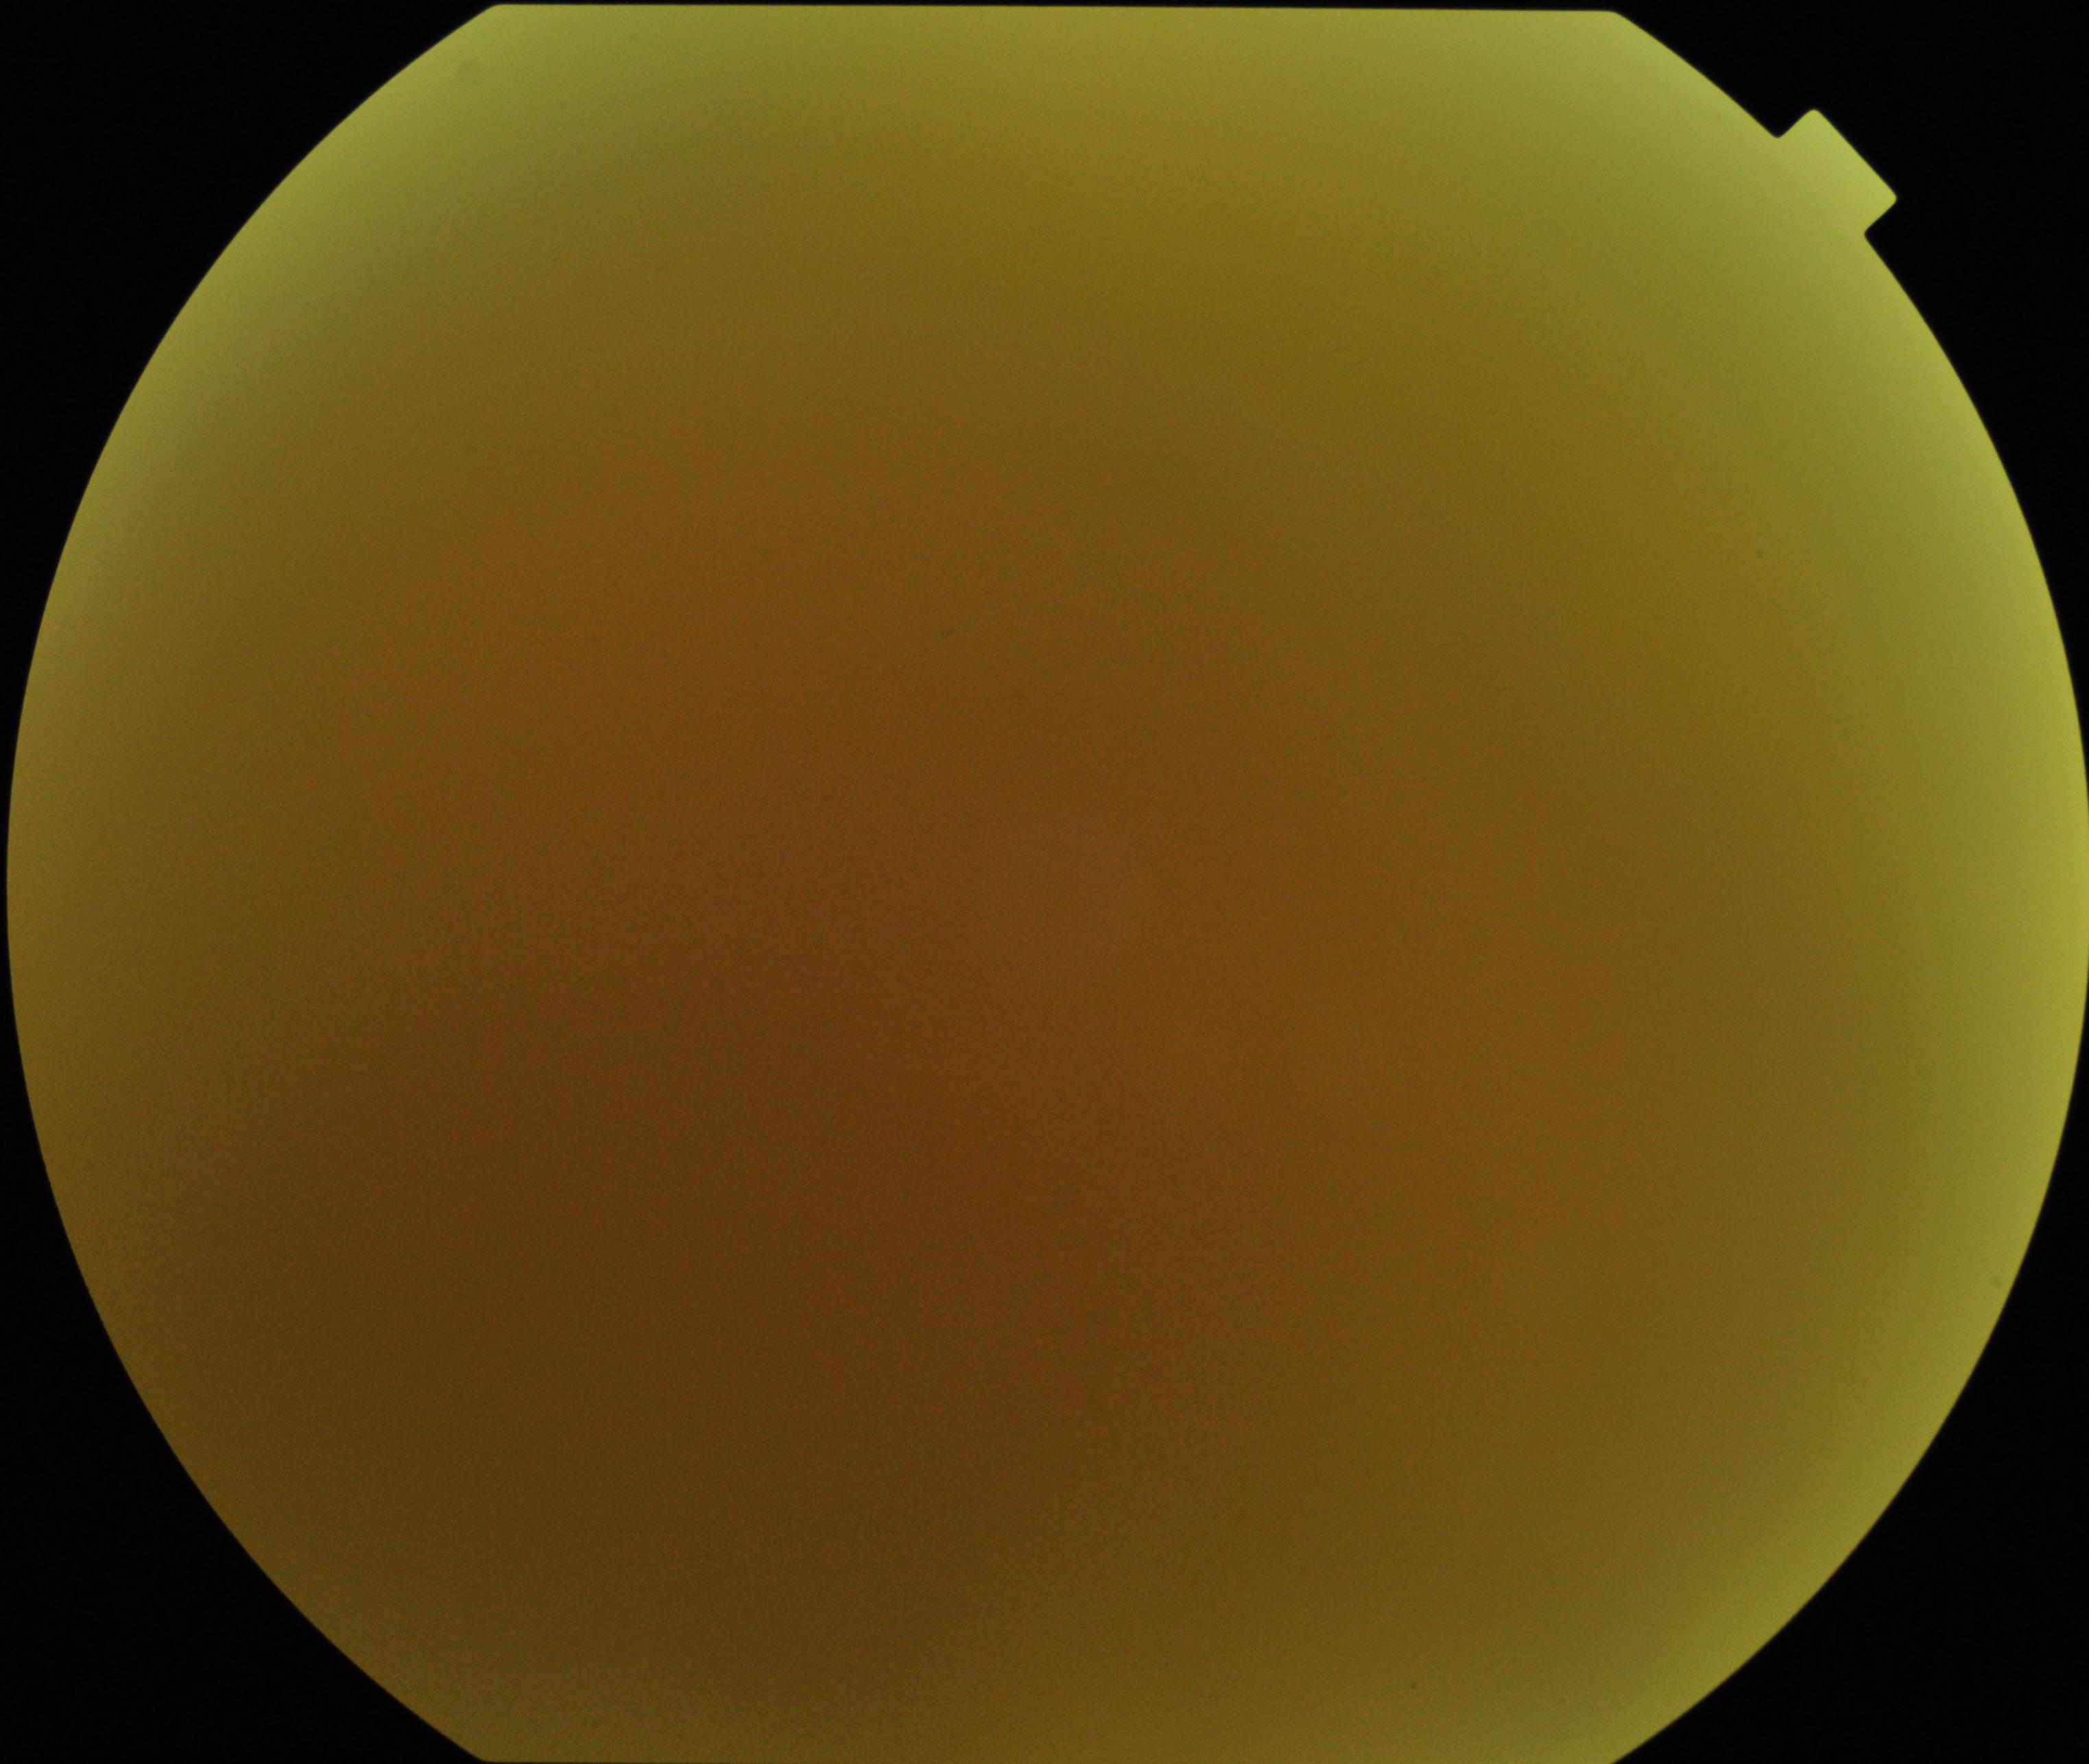 Poor-quality fundus photograph; retinal landmarks are largely obscured. No evidence of proliferative diabetic retinopathy.